Phoenix ICON, 100° FOV · 1240x1240px · pediatric wide-field fundus photograph: 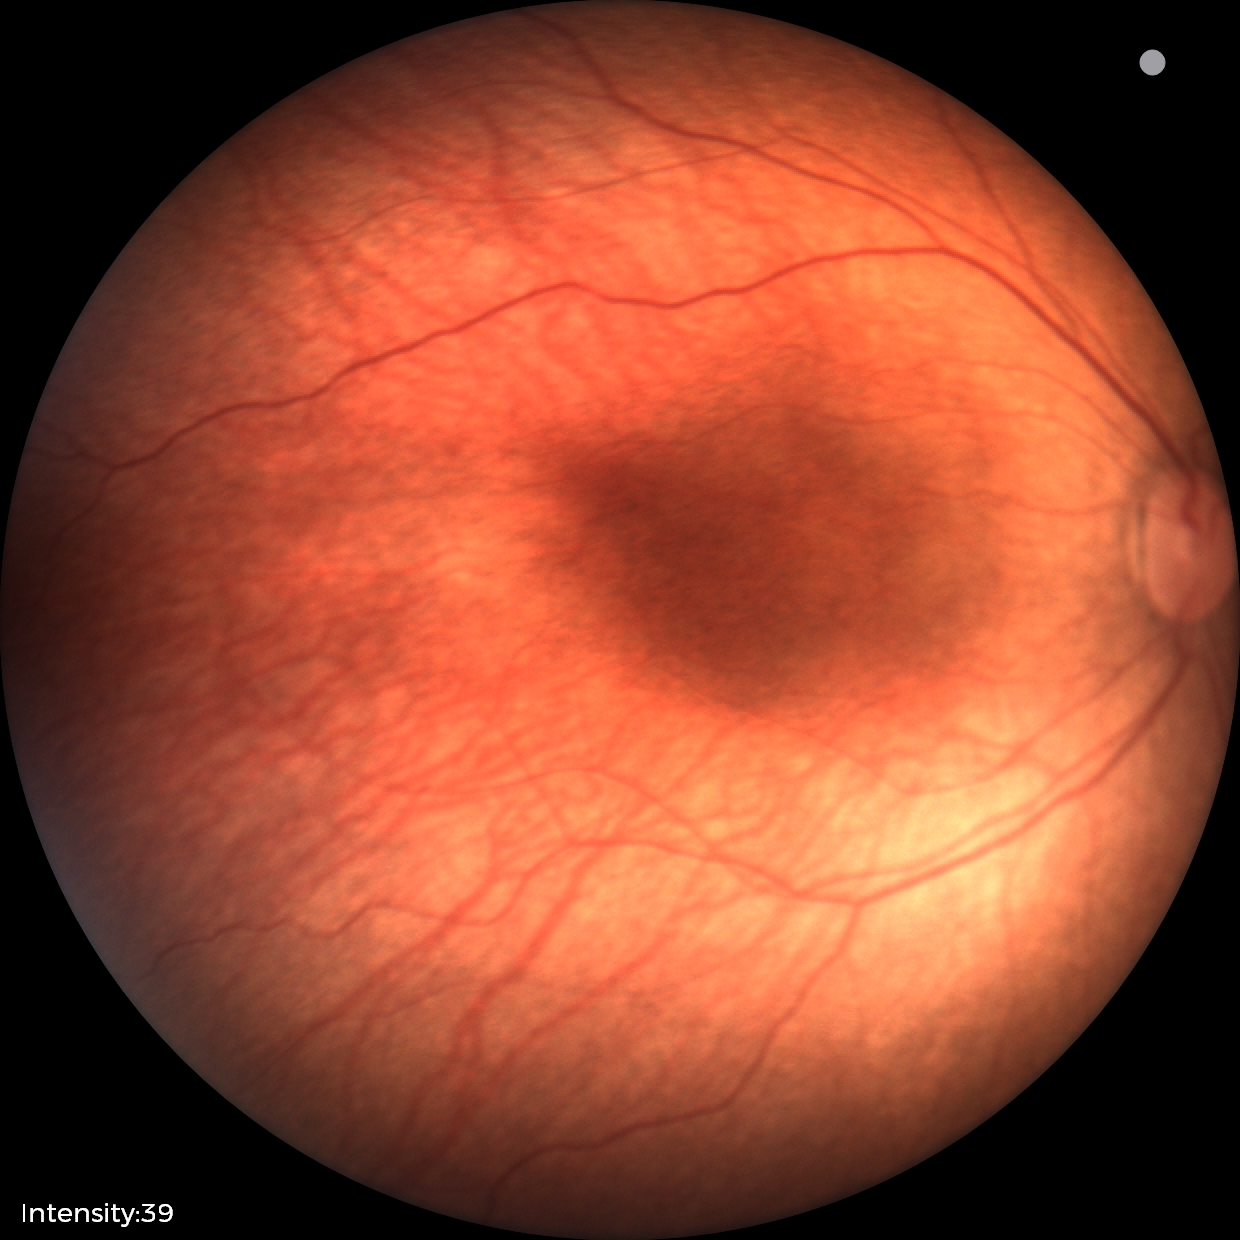
Plus disease: absent | impression: status post retinopathy of prematurity (ROP).